Natus RetCam Envision, 130° FOV; infant wide-field retinal image — 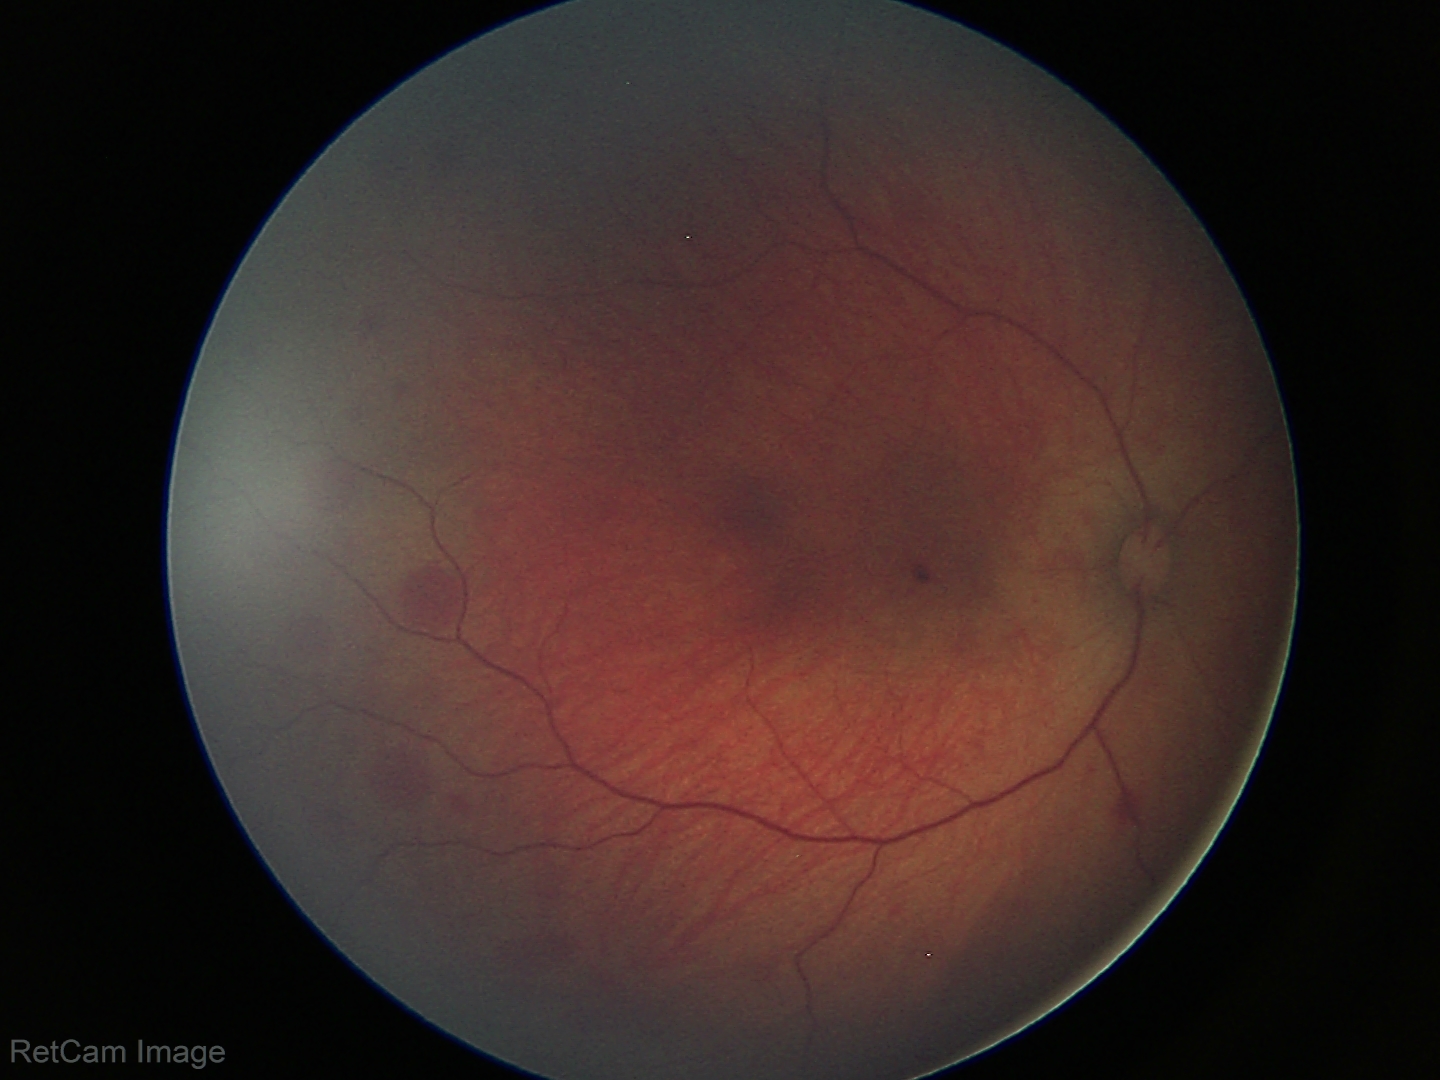
Finding = retinal hemorrhages.